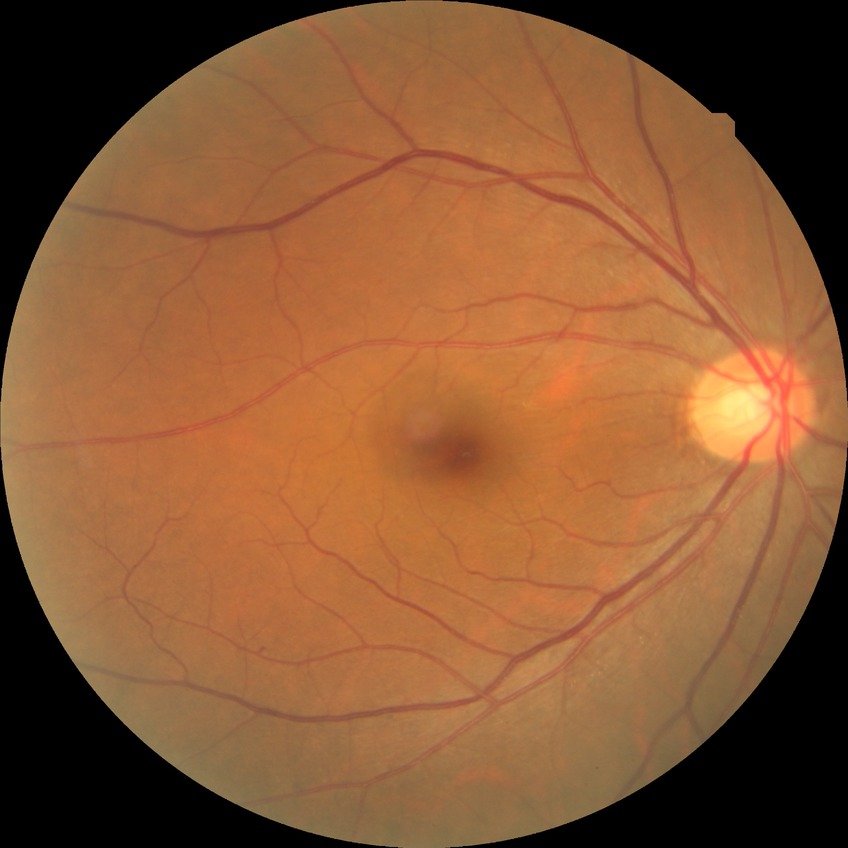

The retinopathy is classified as non-proliferative diabetic retinopathy. Modified Davis classification: simple diabetic retinopathy.